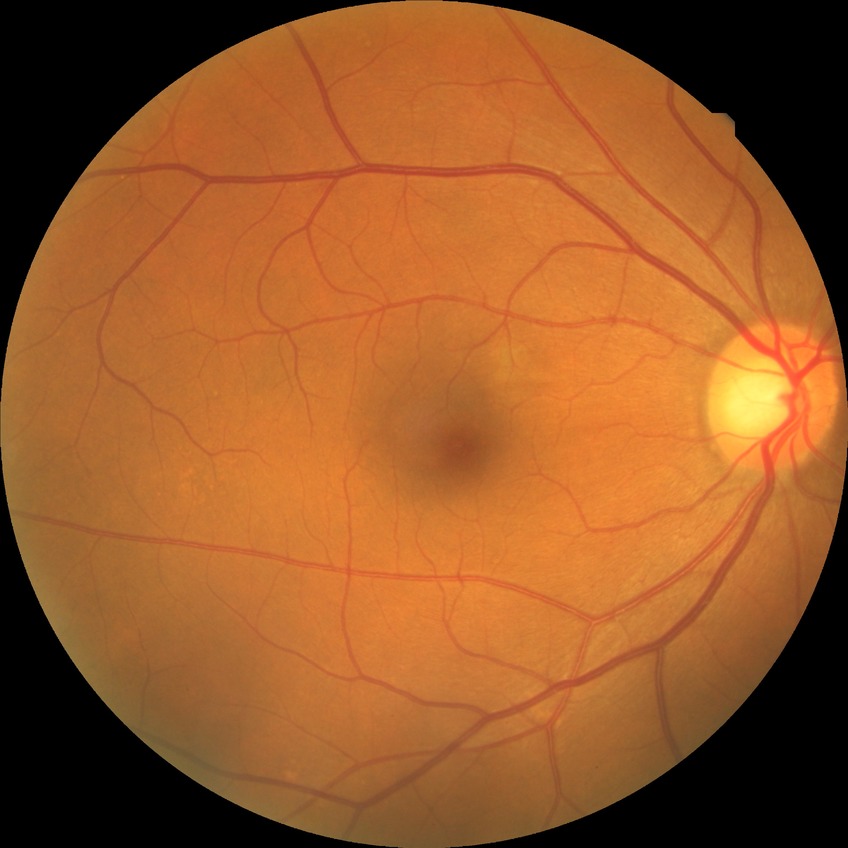

Diabetic retinopathy (DR) is NDR (no diabetic retinopathy).